45° field of view:
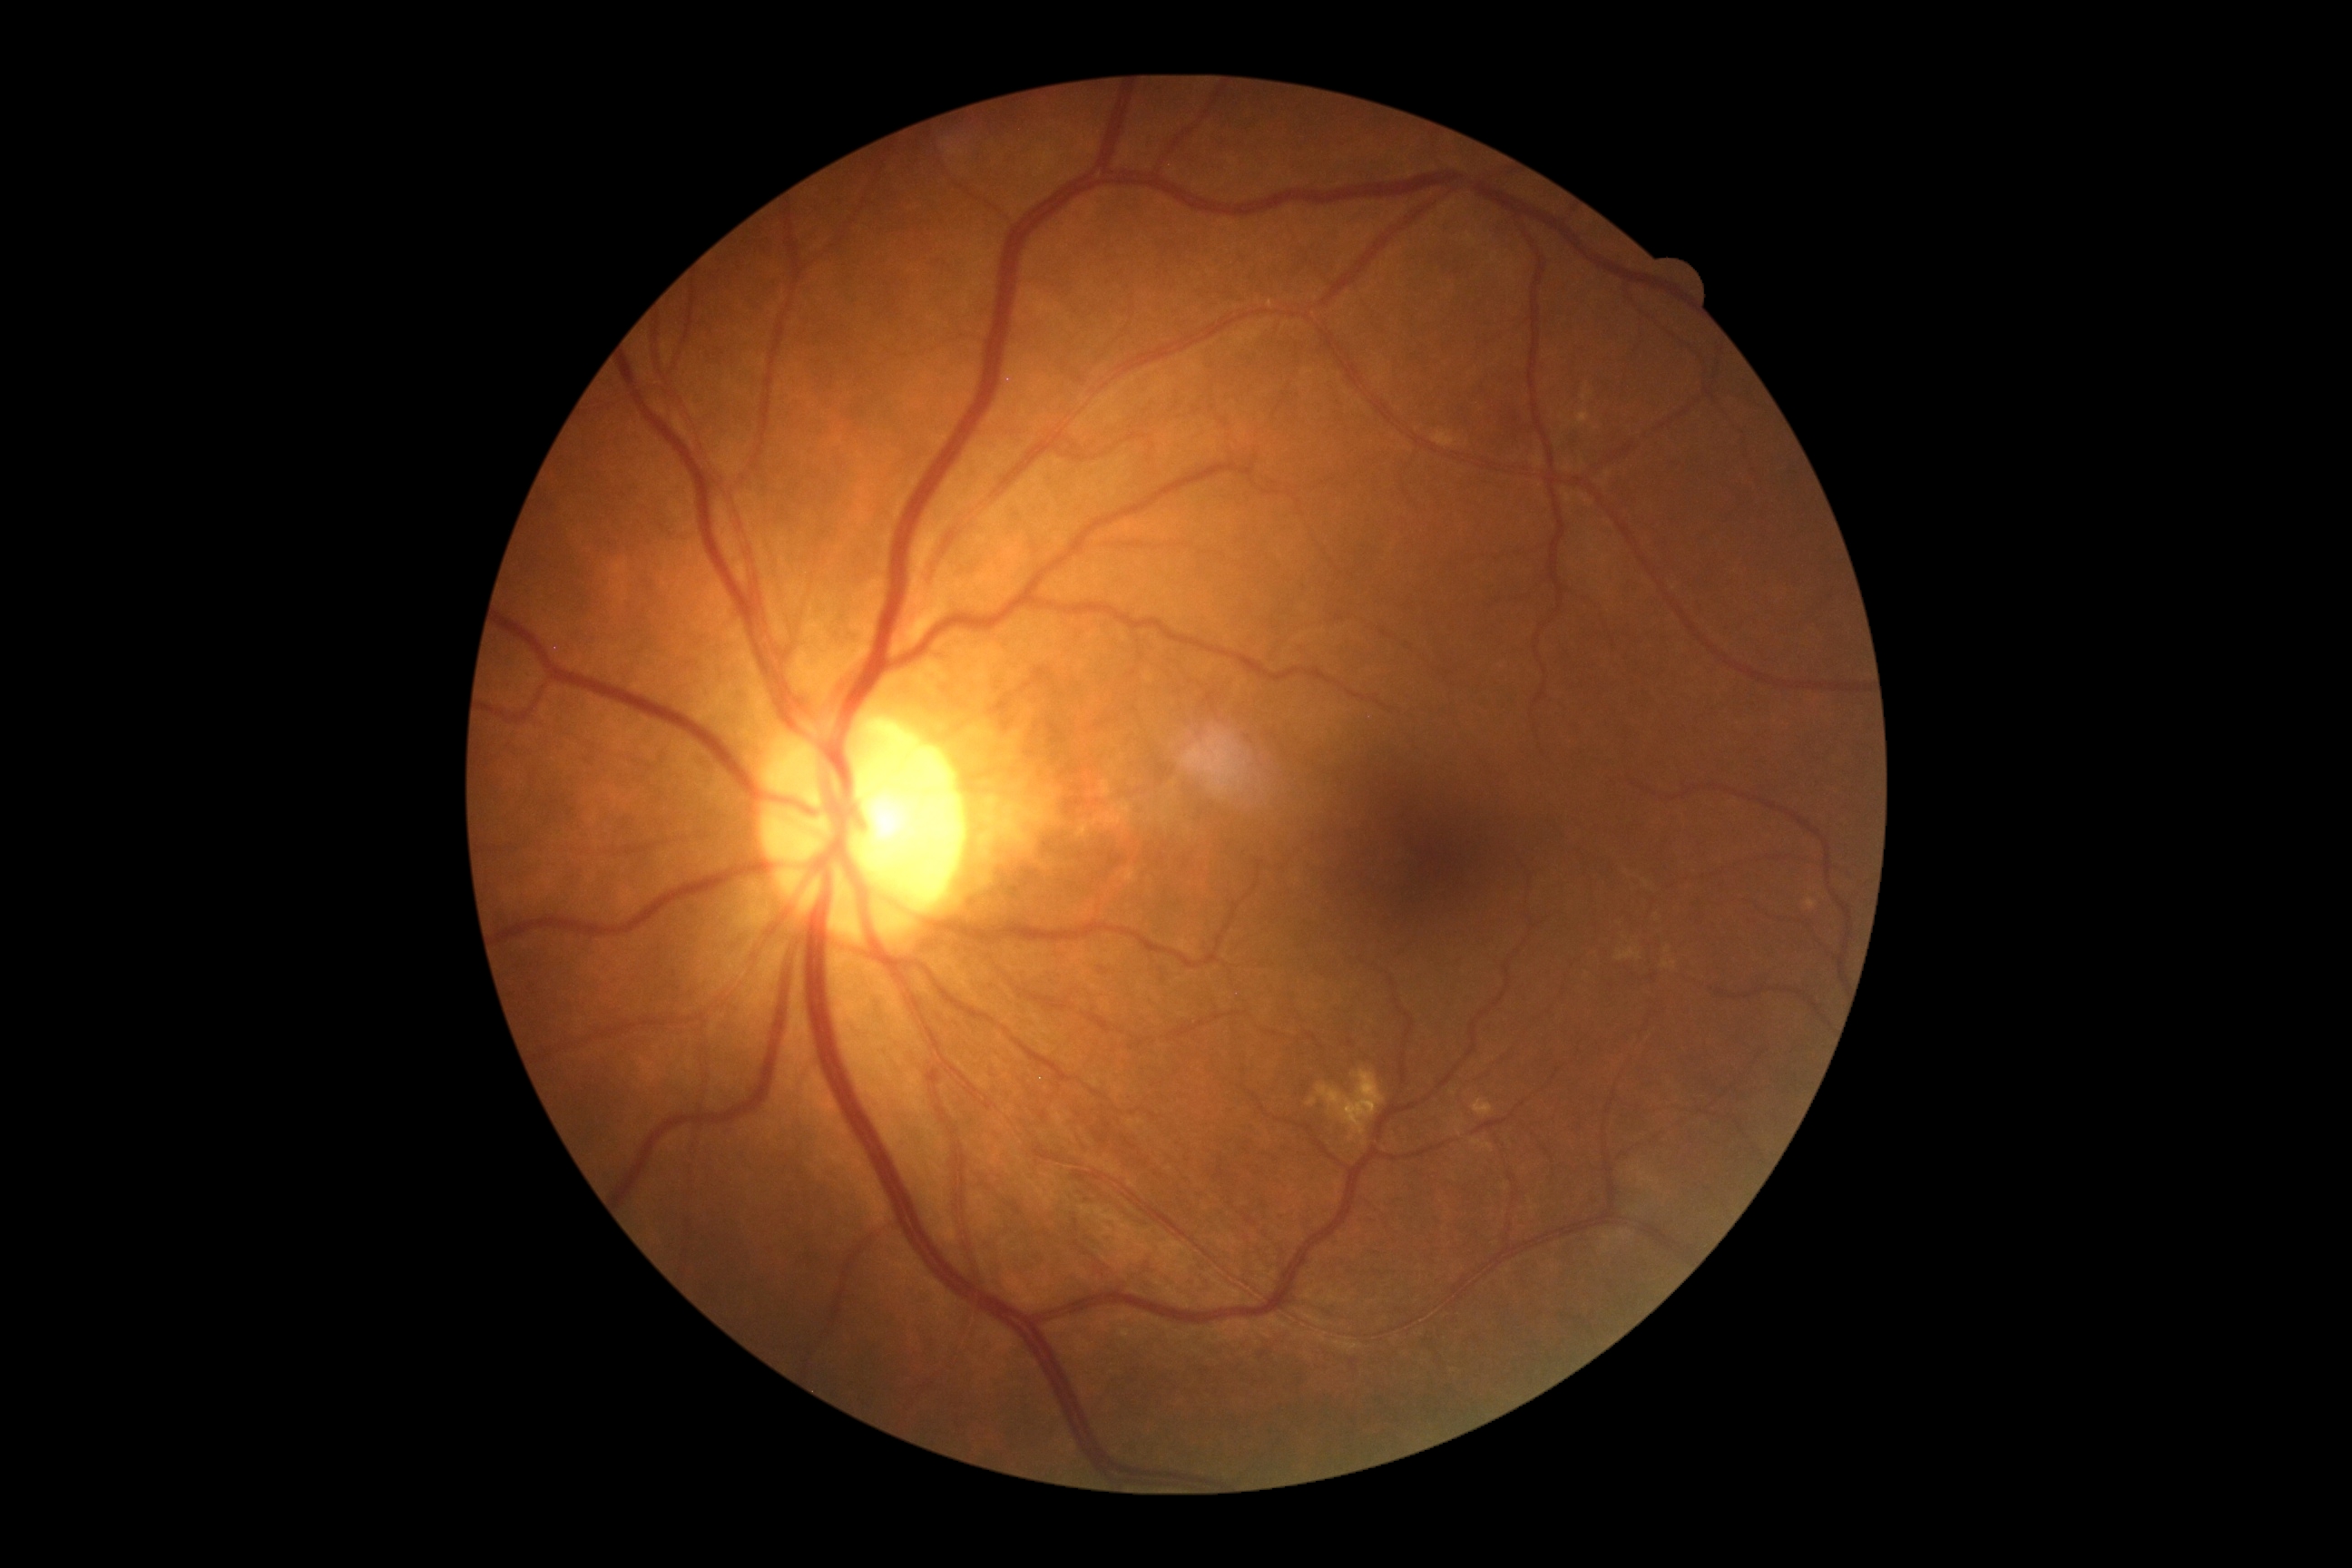
  dr_grade: no apparent diabetic retinopathy (grade 0)